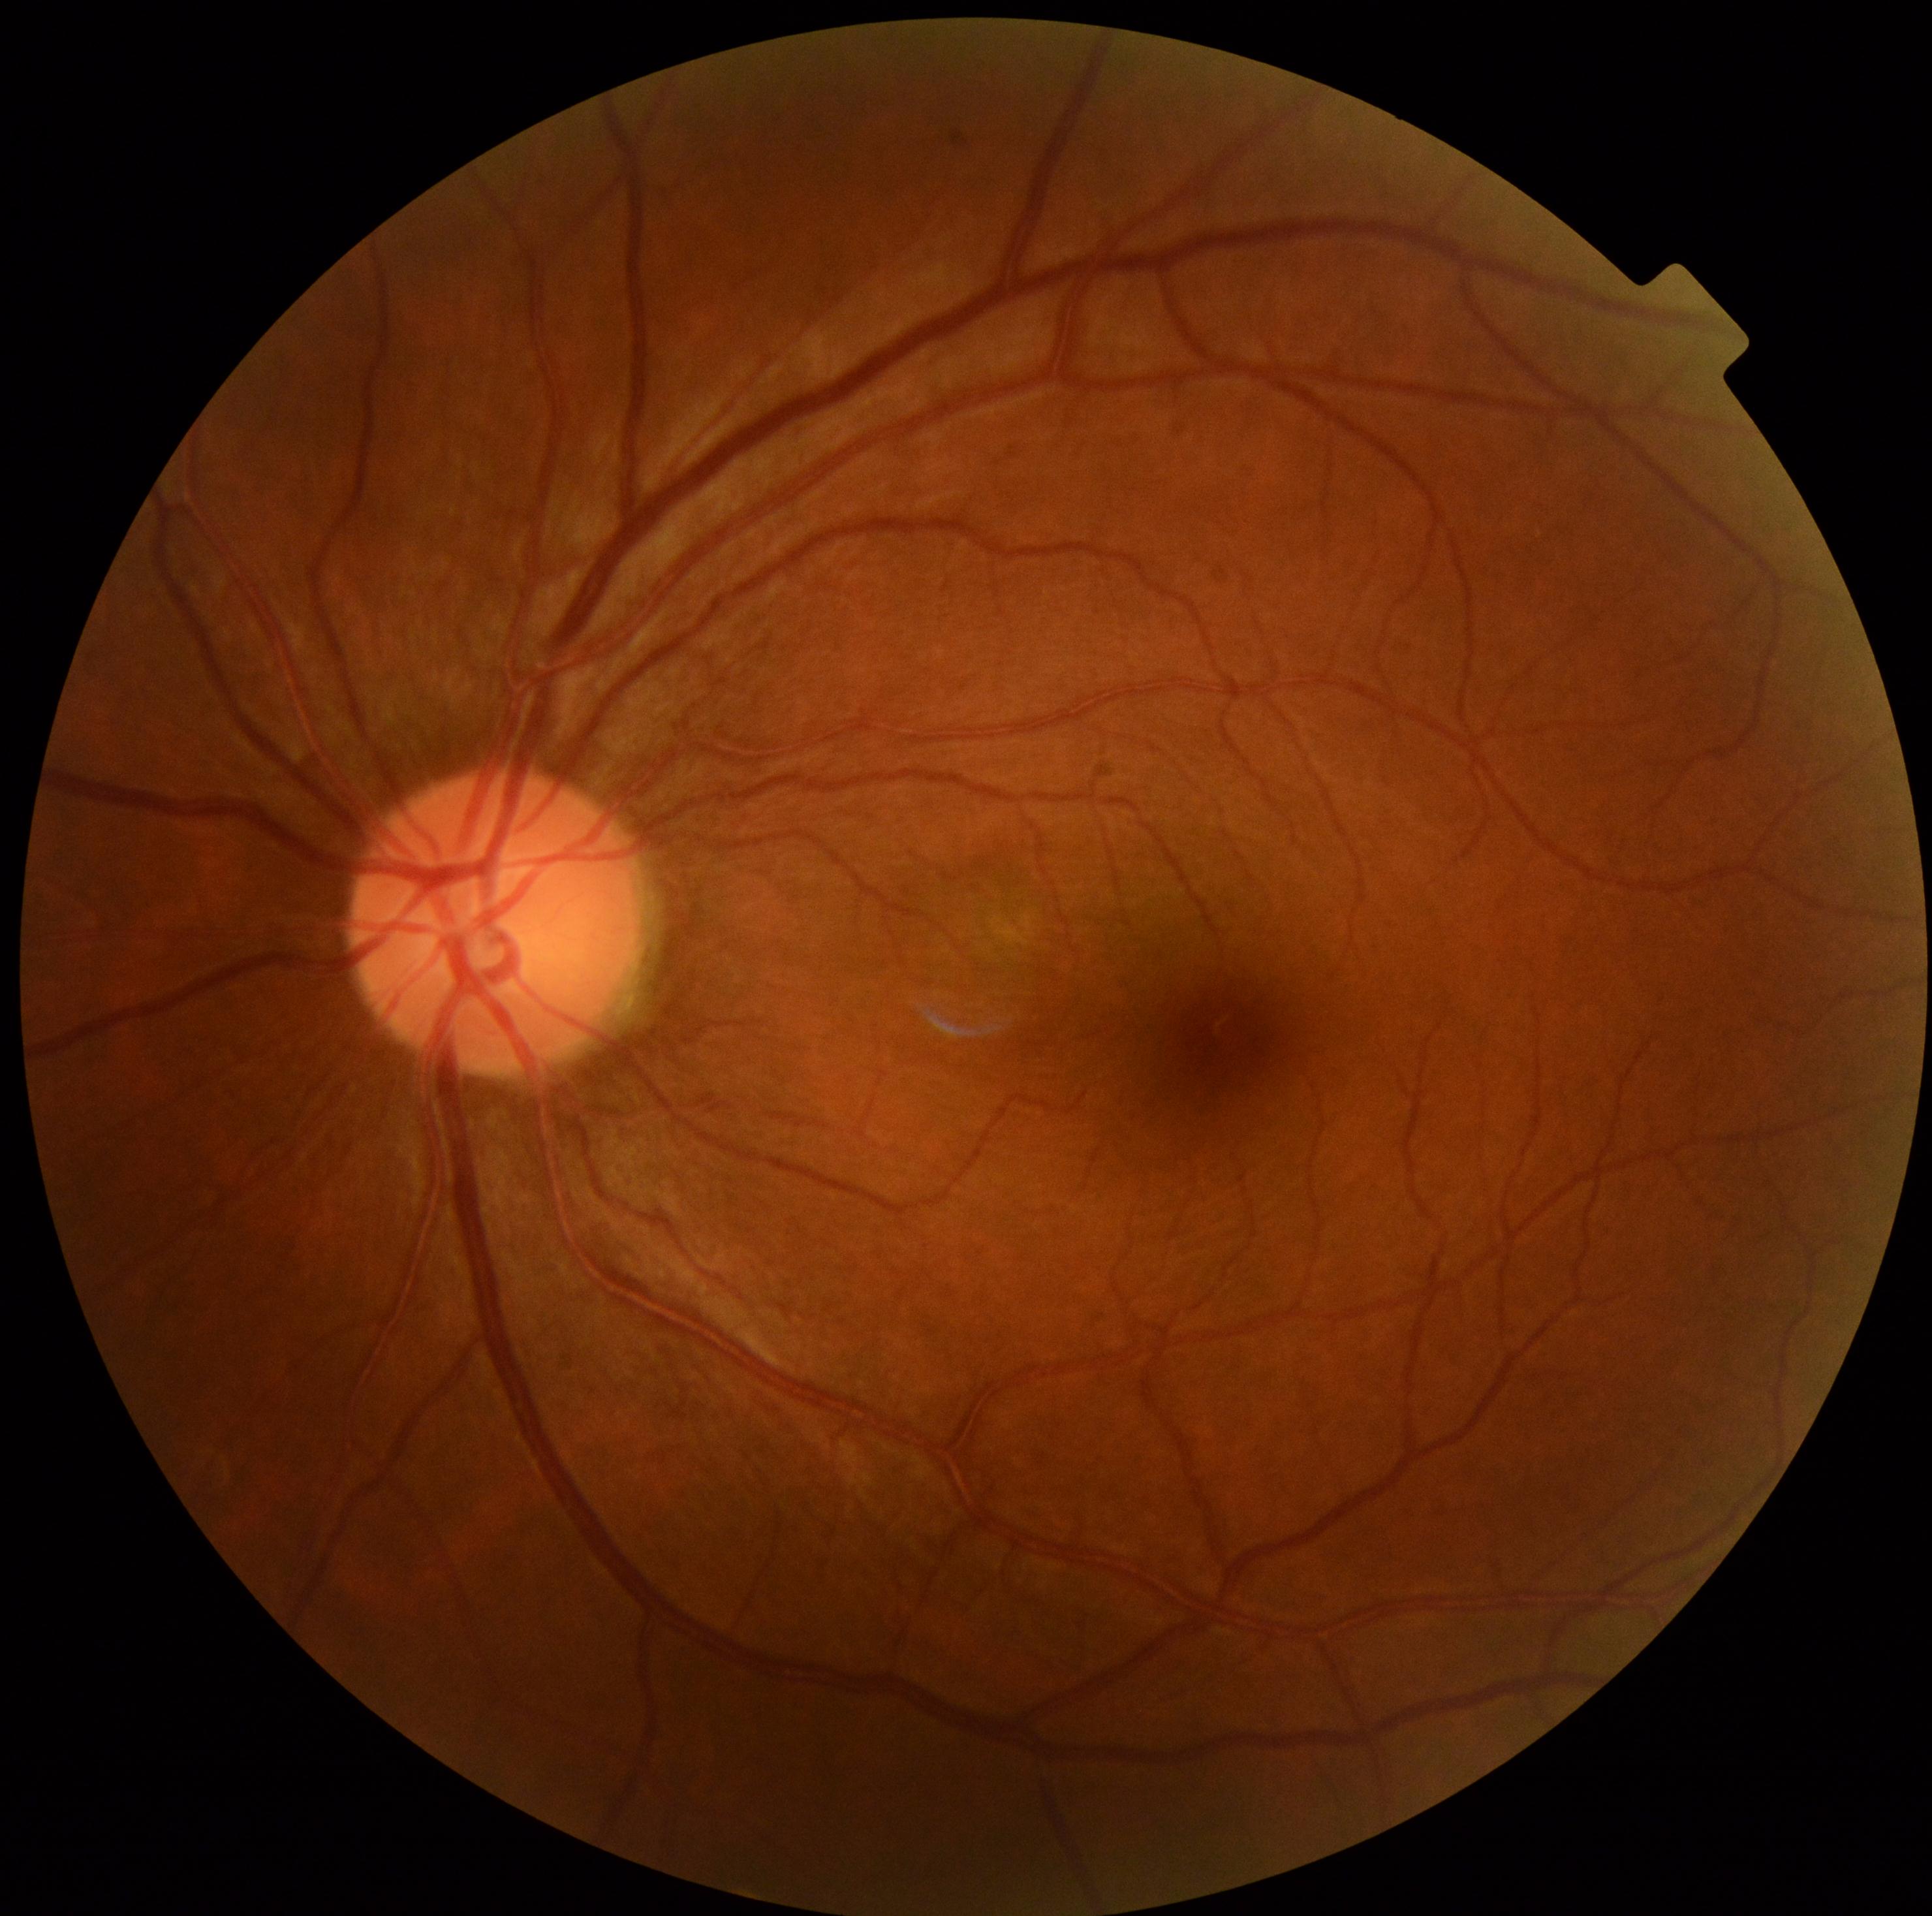

No diabetic retinal disease findings. Diabetic retinopathy grade: no apparent diabetic retinopathy (0).